Wide-field contact fundus photograph of an infant: 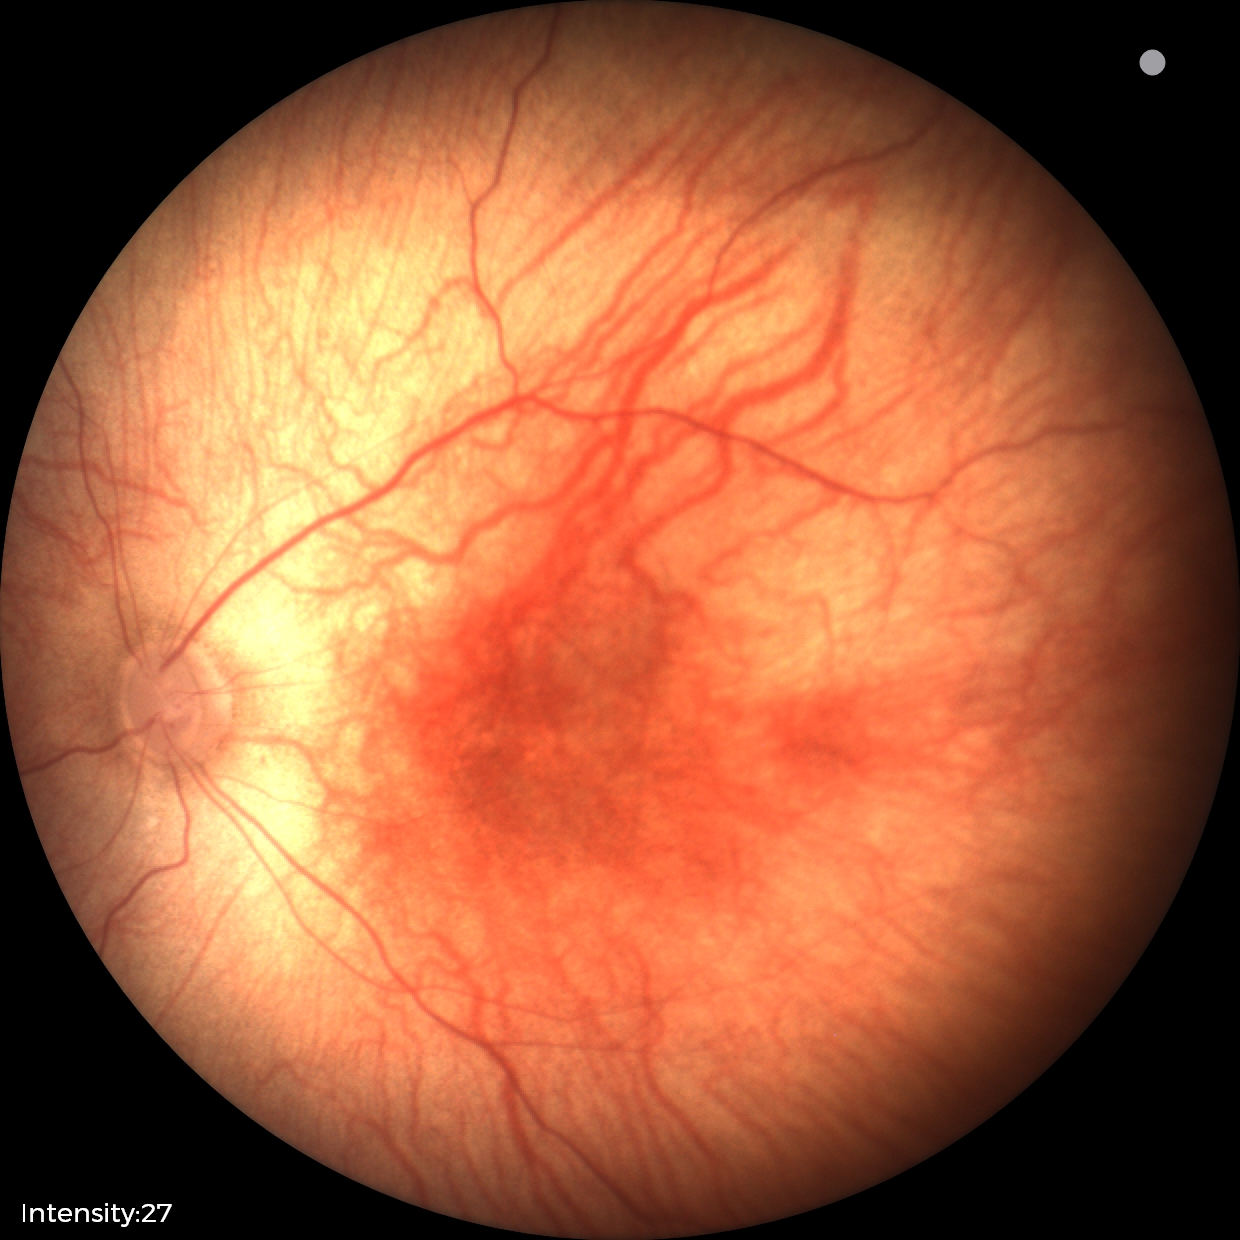

Impression: normal retinal appearance.